CFP · 45° FOV · image size 1380x1382:
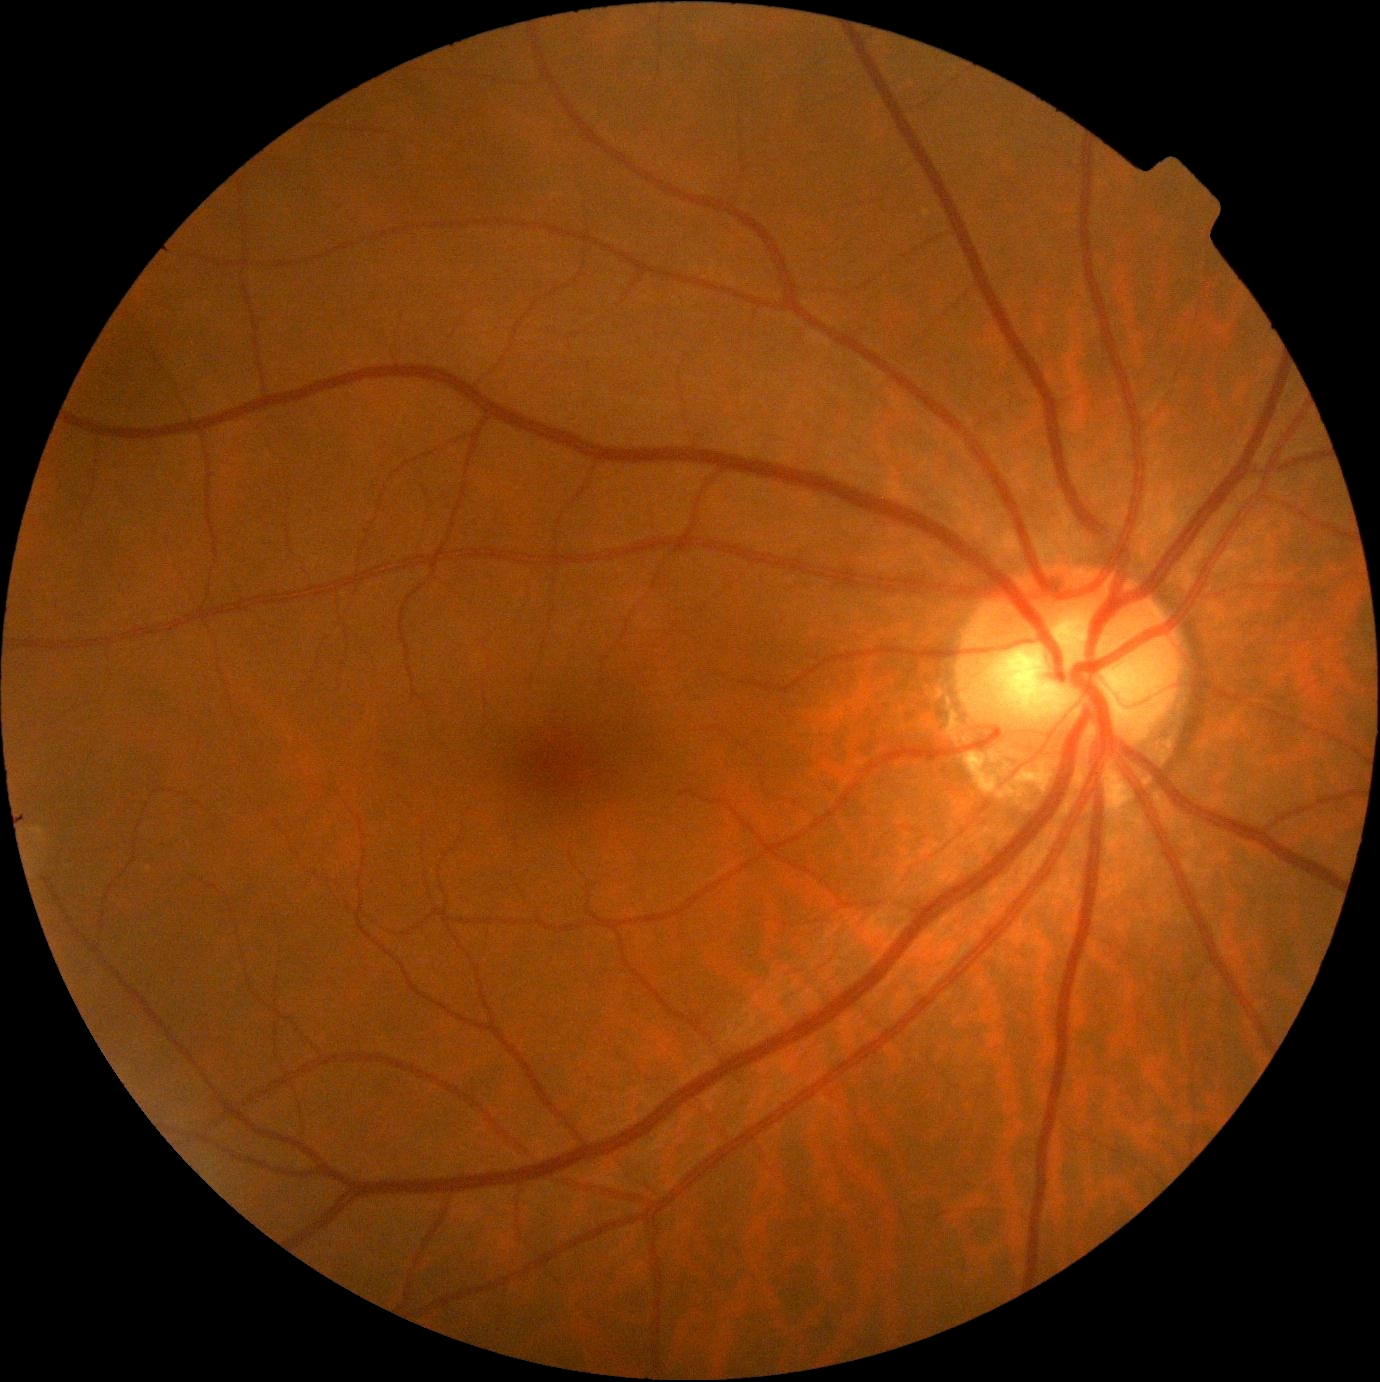 DR severity is 0/4.